Field includes the optic disc and macula.
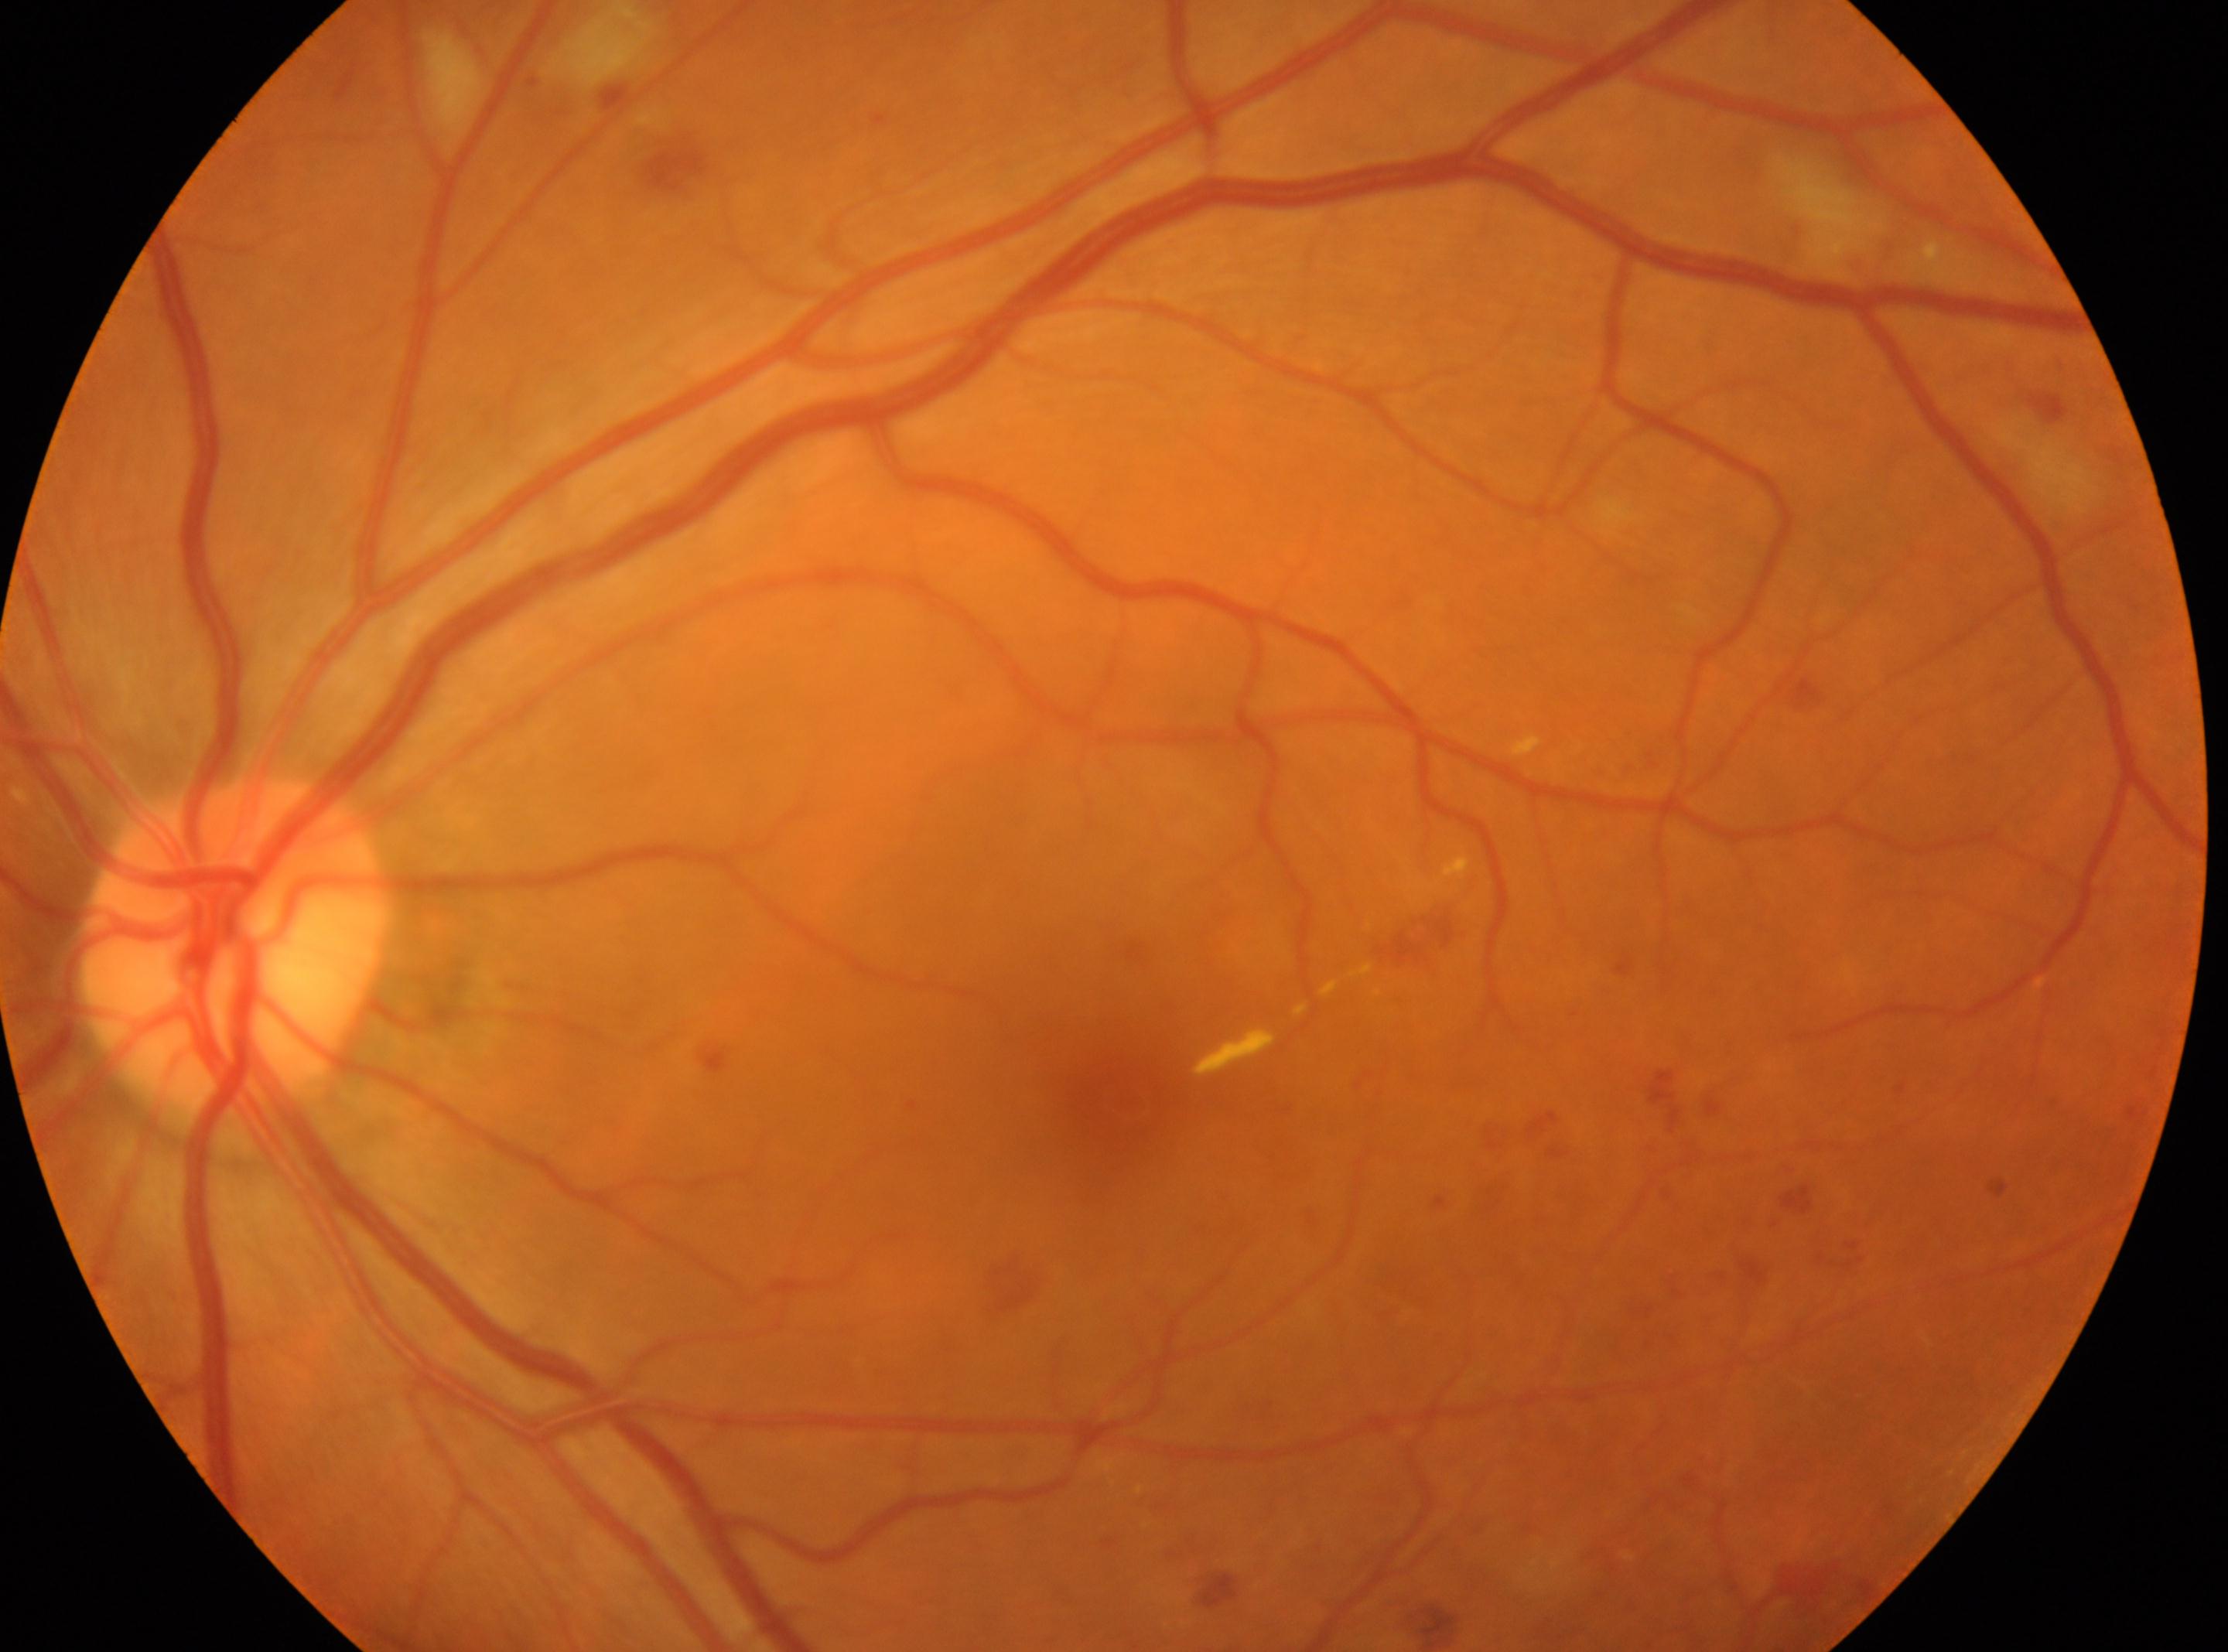
Q: DR stage?
A: grade 2 (moderate NPDR)
Q: What disease class is present?
A: non-proliferative diabetic retinopathy
Q: What is the laterality?
A: left eye
Q: Where is the optic disc?
A: 232px, 942px
Q: Locate the fovea.
A: 1119px, 1106px